No pharmacologic dilation. 45-degree field of view. Retinal fundus photograph.
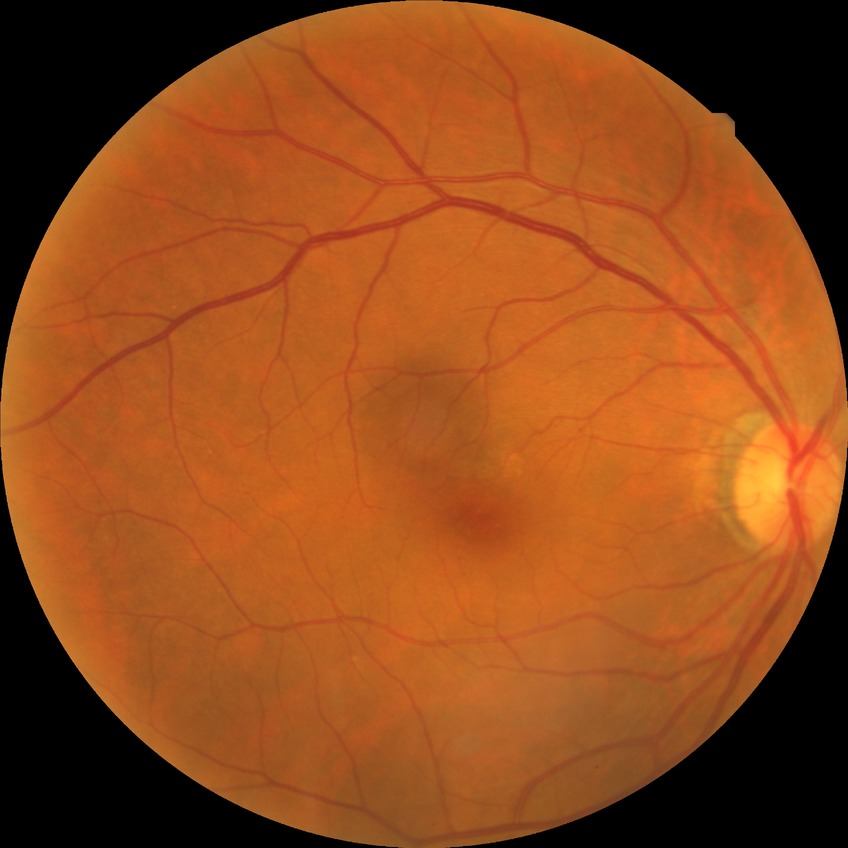

Diabetic retinopathy (DR): no diabetic retinopathy (NDR).